Infant wide-field retinal image.
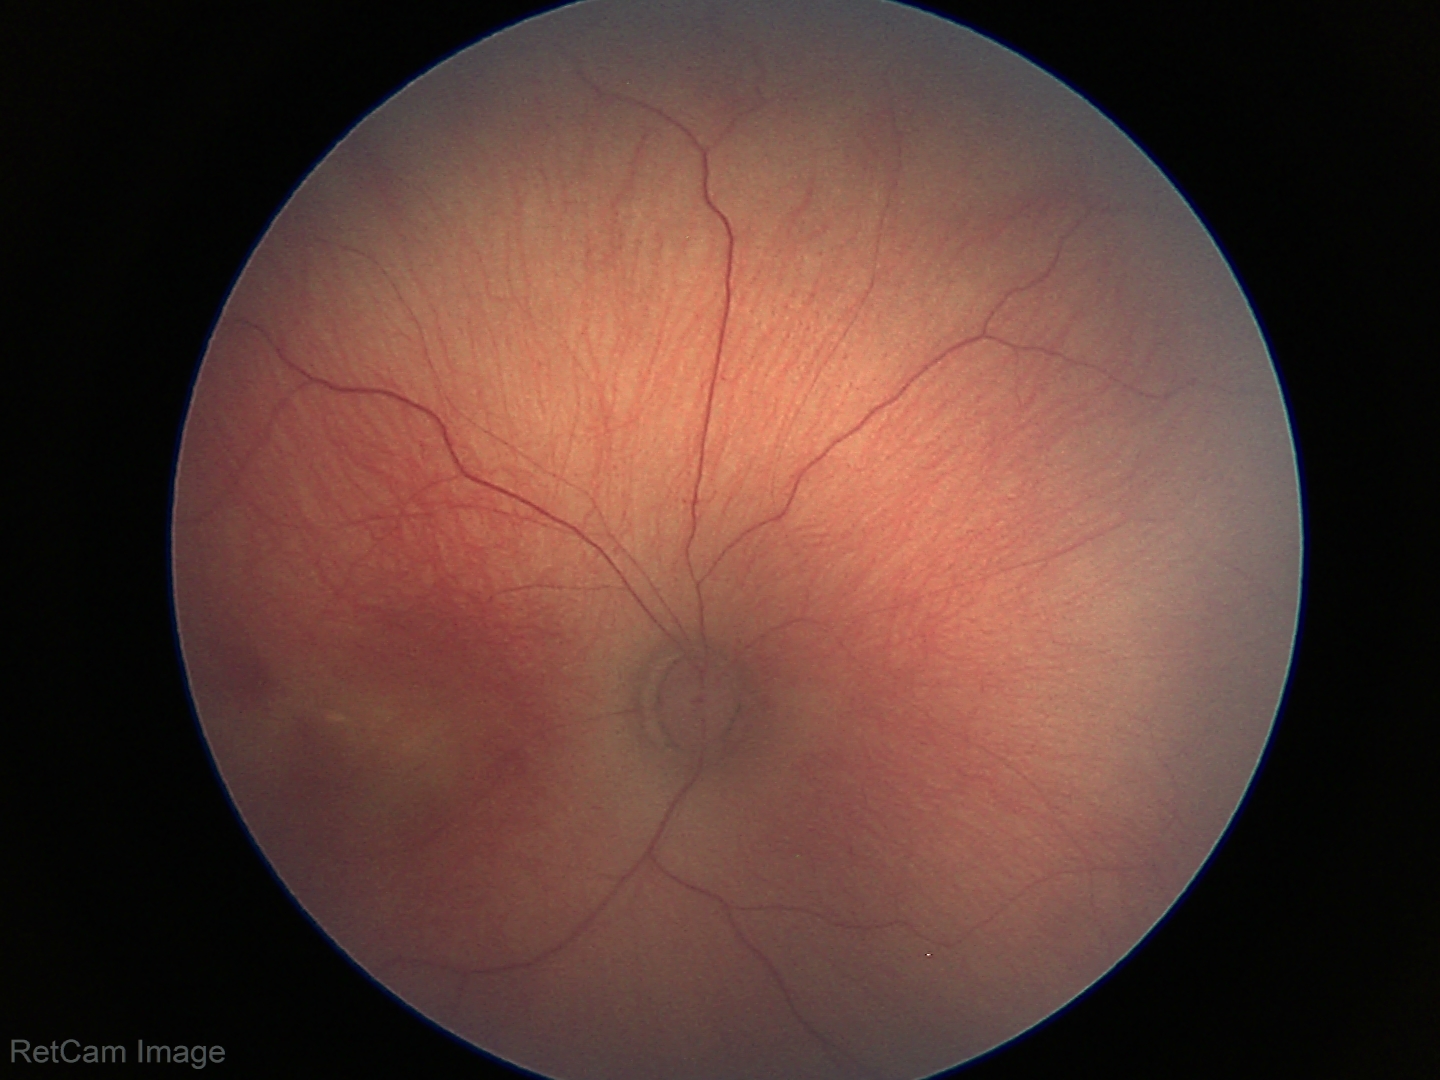
Examination diagnosed as status post retinopathy of prematurity (ROP).